Image size 1659x2212
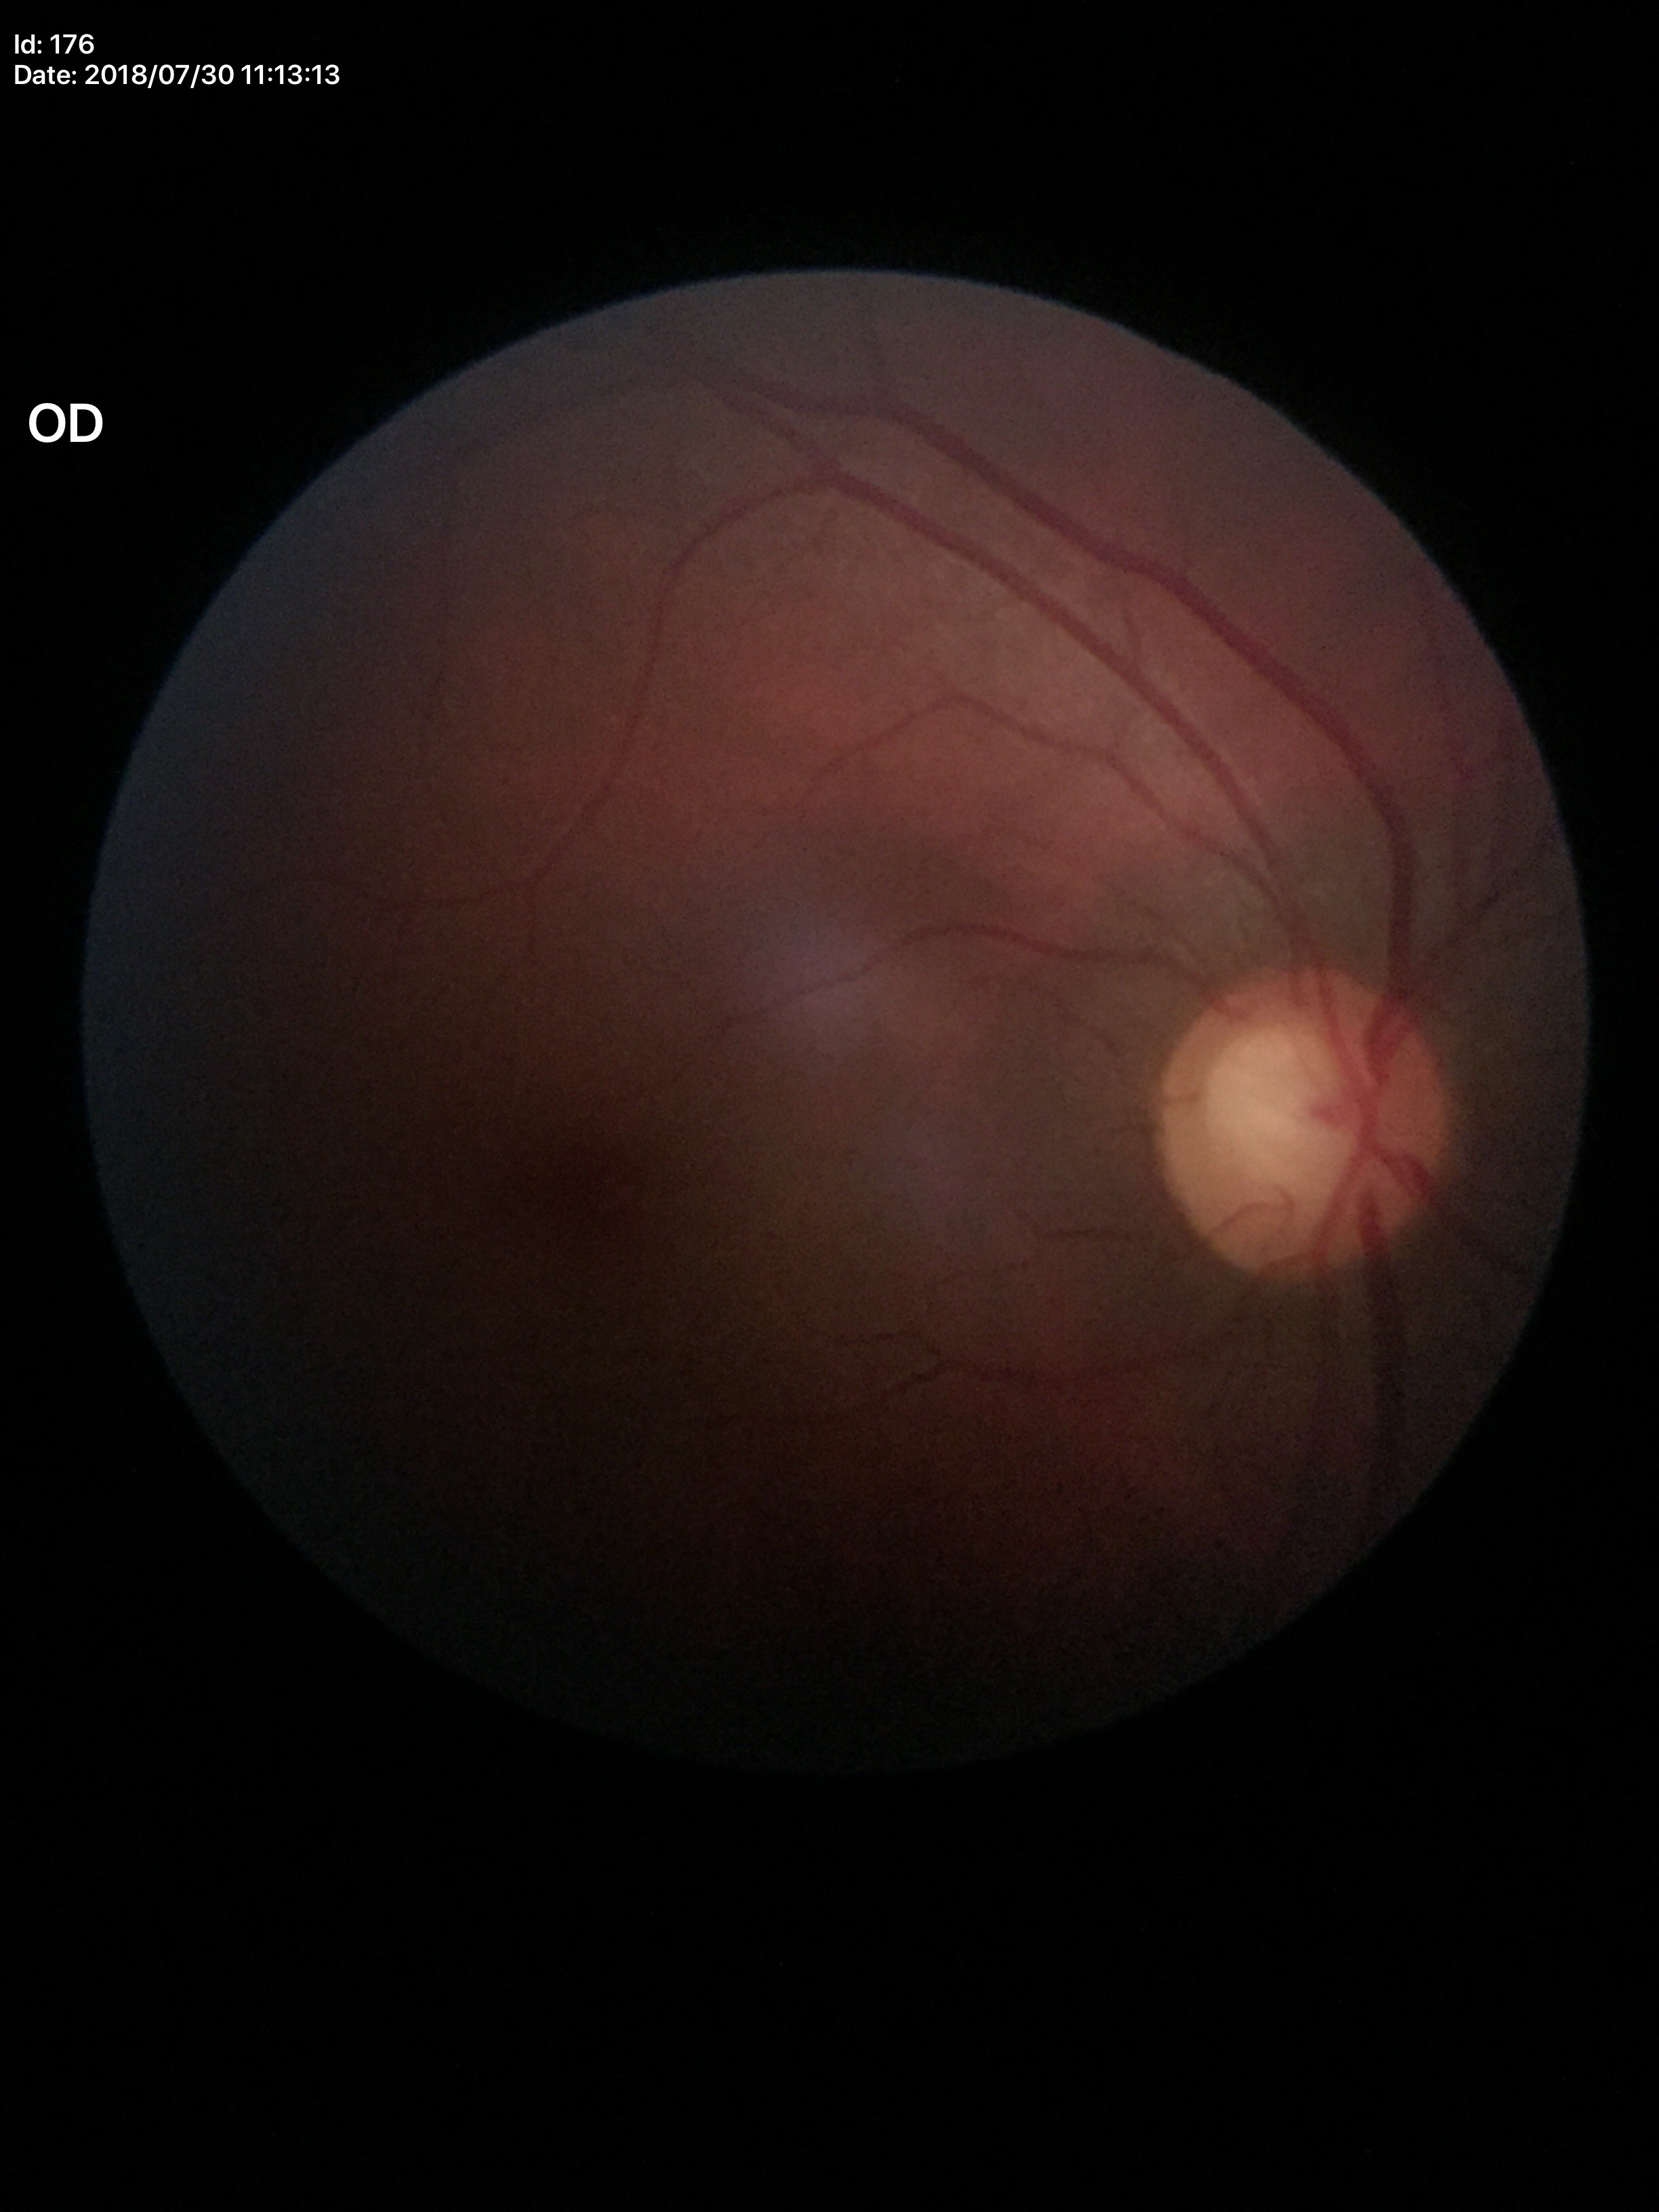

Q: What is the glaucoma assessment?
A: suspicious
Q: What is the vertical cup-to-disc ratio?
A: 0.62
Q: Horizontal CDR?
A: 0.66